Image size 848x848; camera: NIDEK AFC-230: 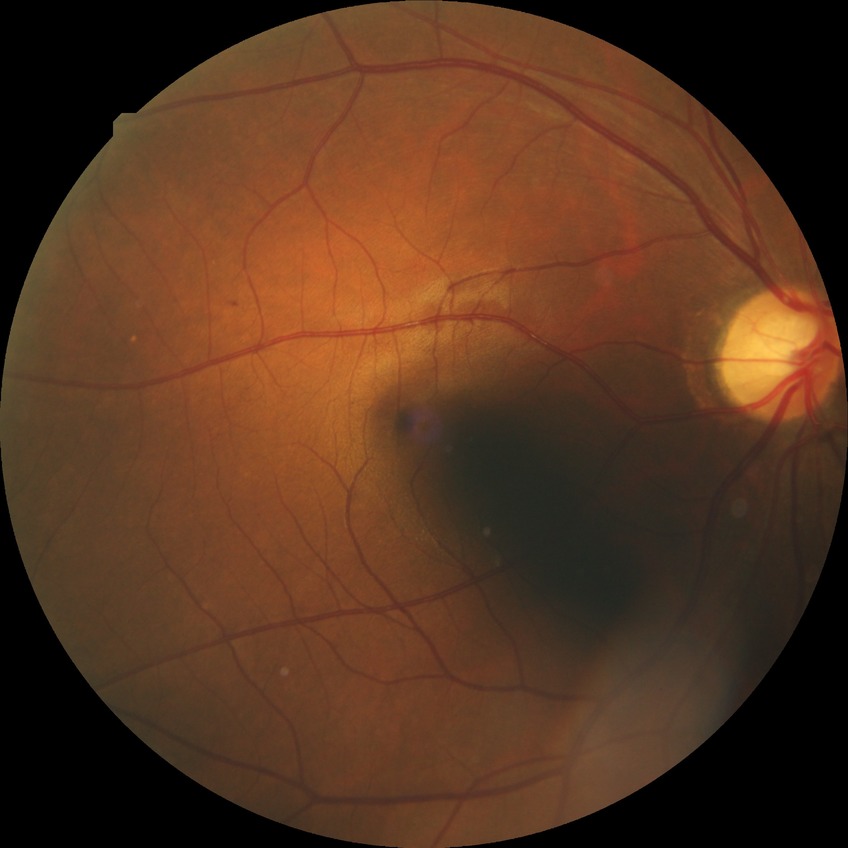

Assessment:
* diabetic retinopathy (DR): simple diabetic retinopathy (SDR)
* DR class: non-proliferative diabetic retinopathy